45-degree field of view · no pharmacologic dilation: 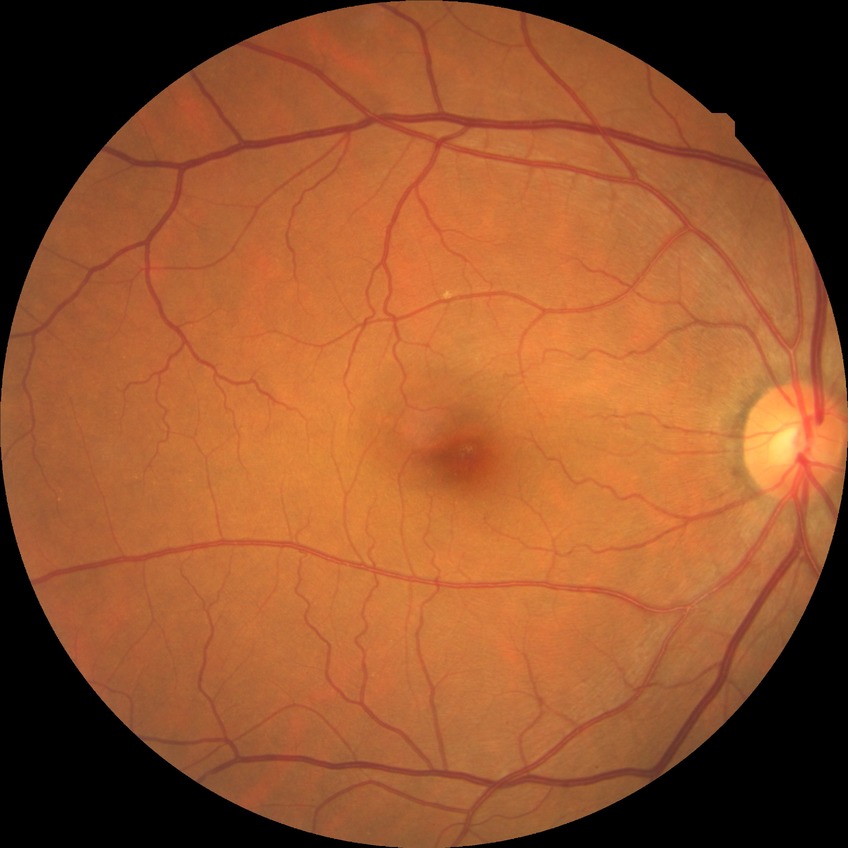

Retinopathy grade is no diabetic retinopathy.